Retinal fundus photograph · 45-degree field of view · 2352x1568
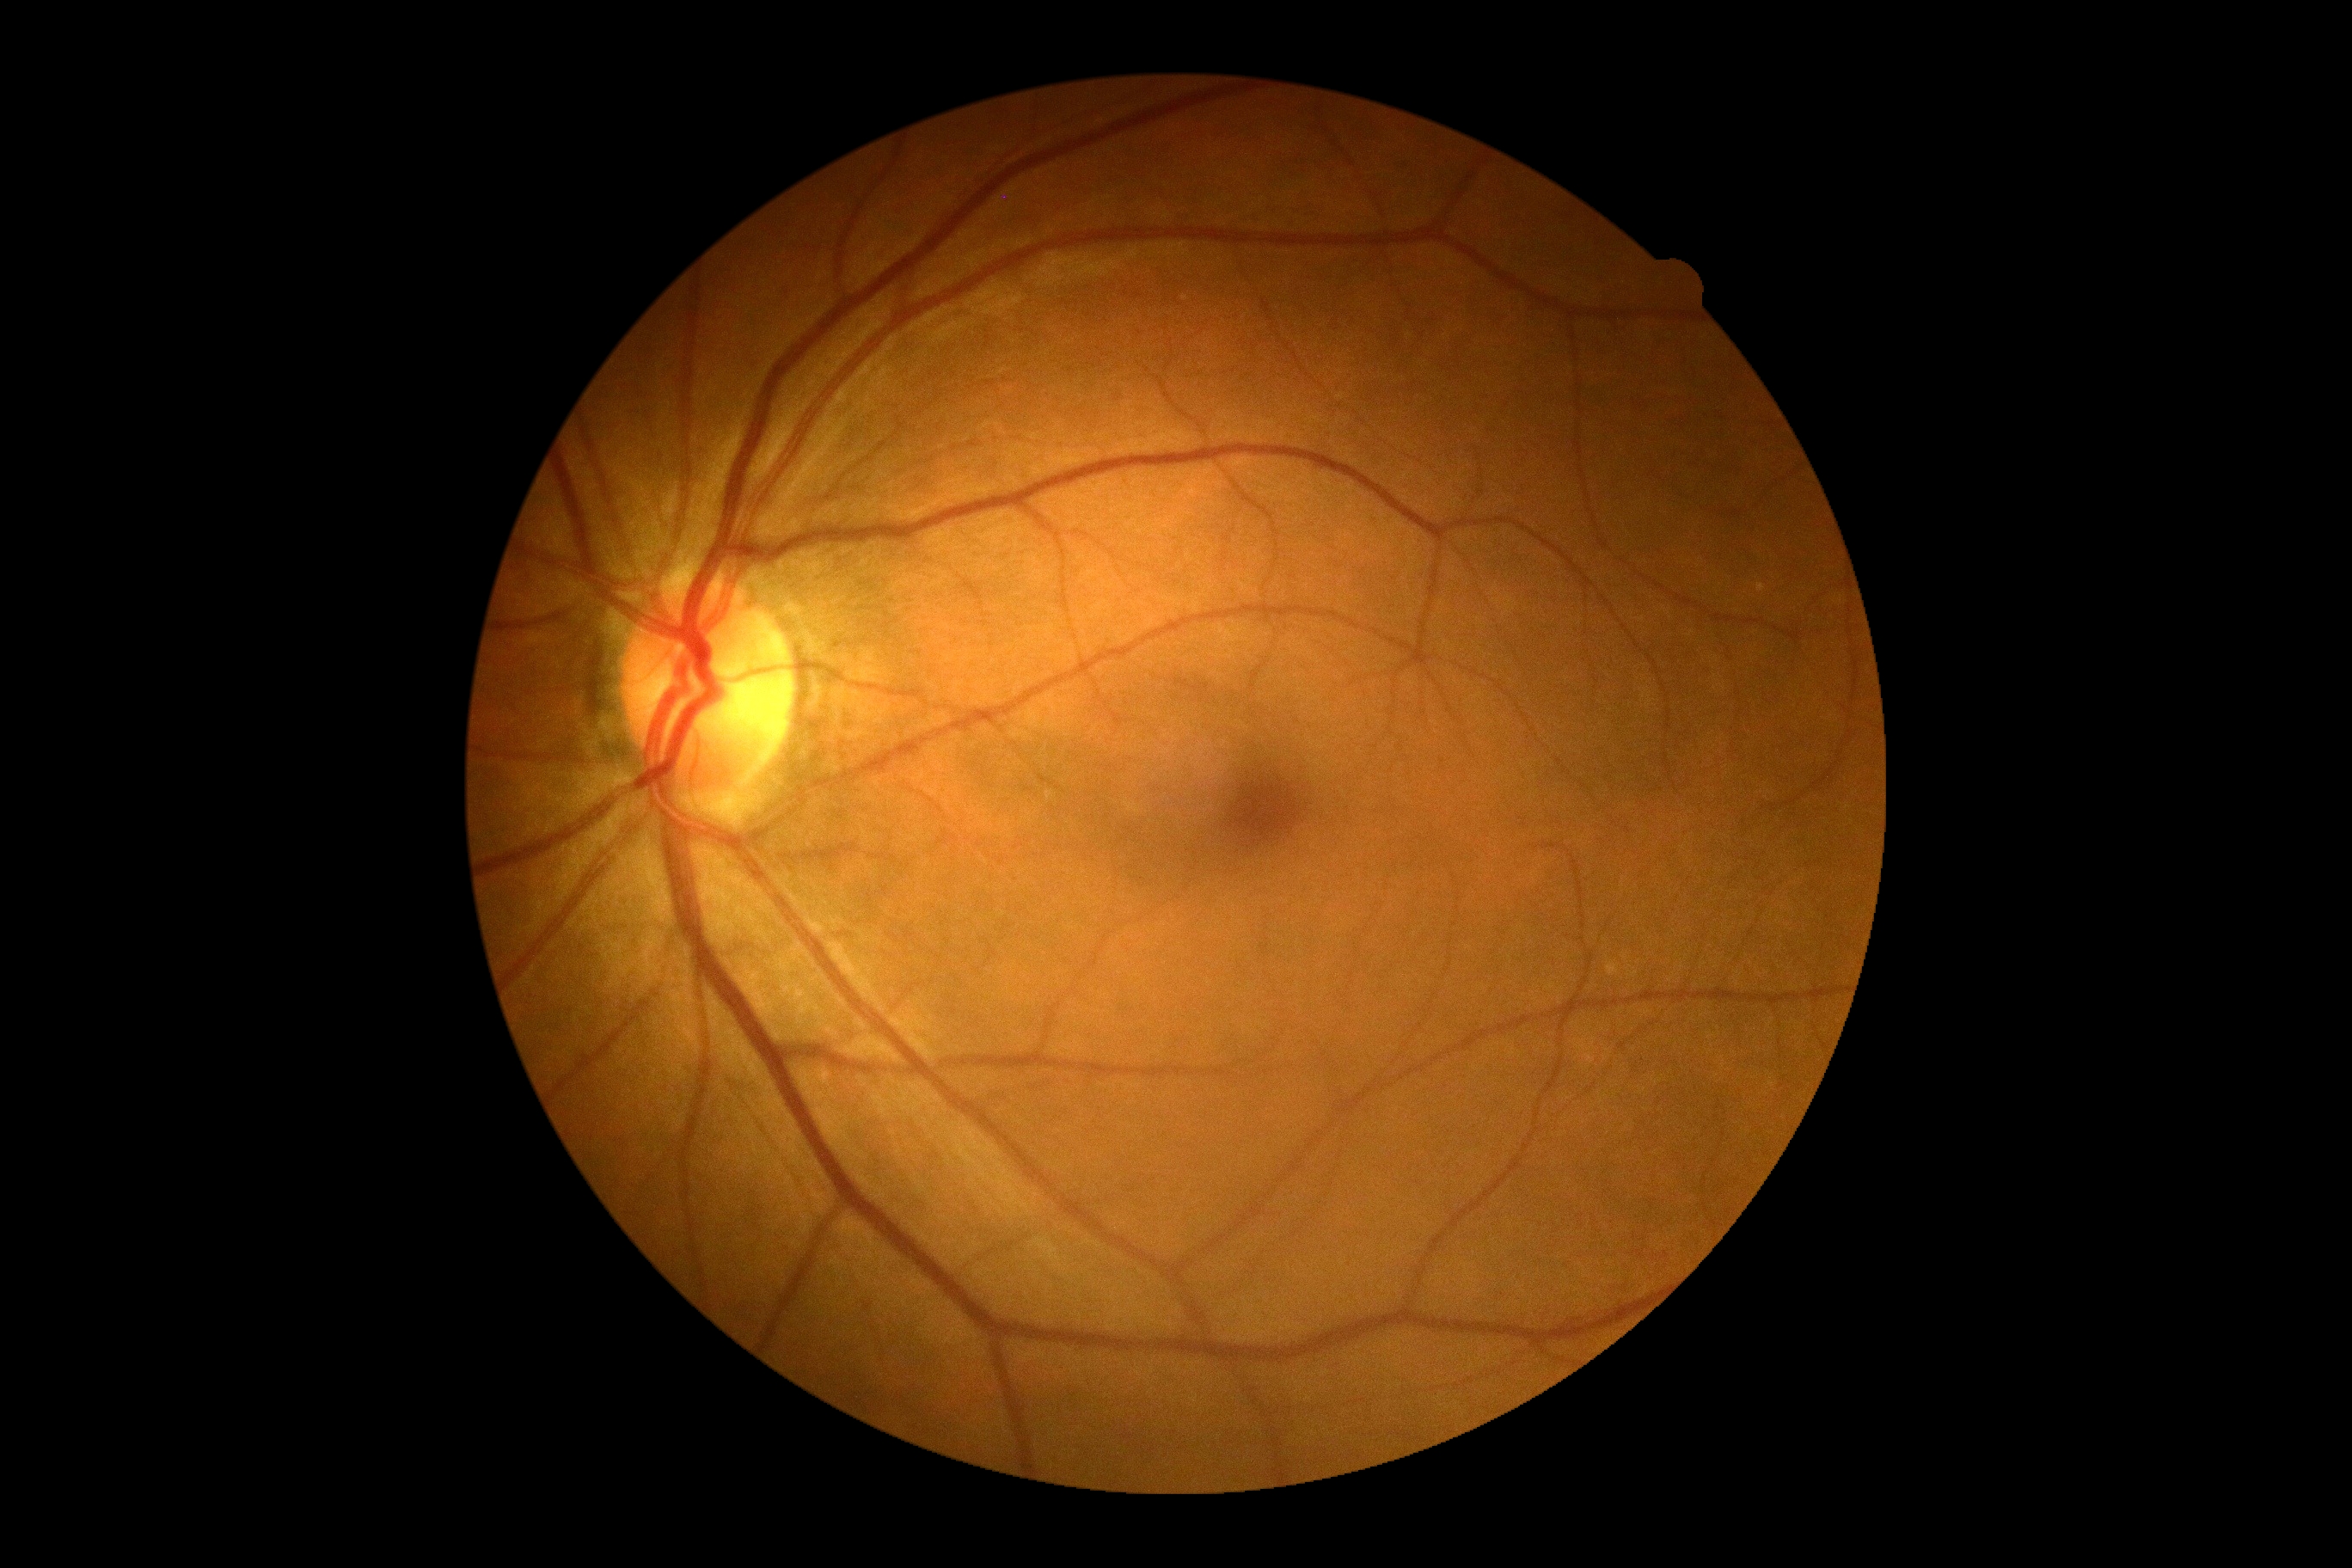

{"dr_grade": "grade 0", "dr_impression": "no DR findings"}